Color fundus image
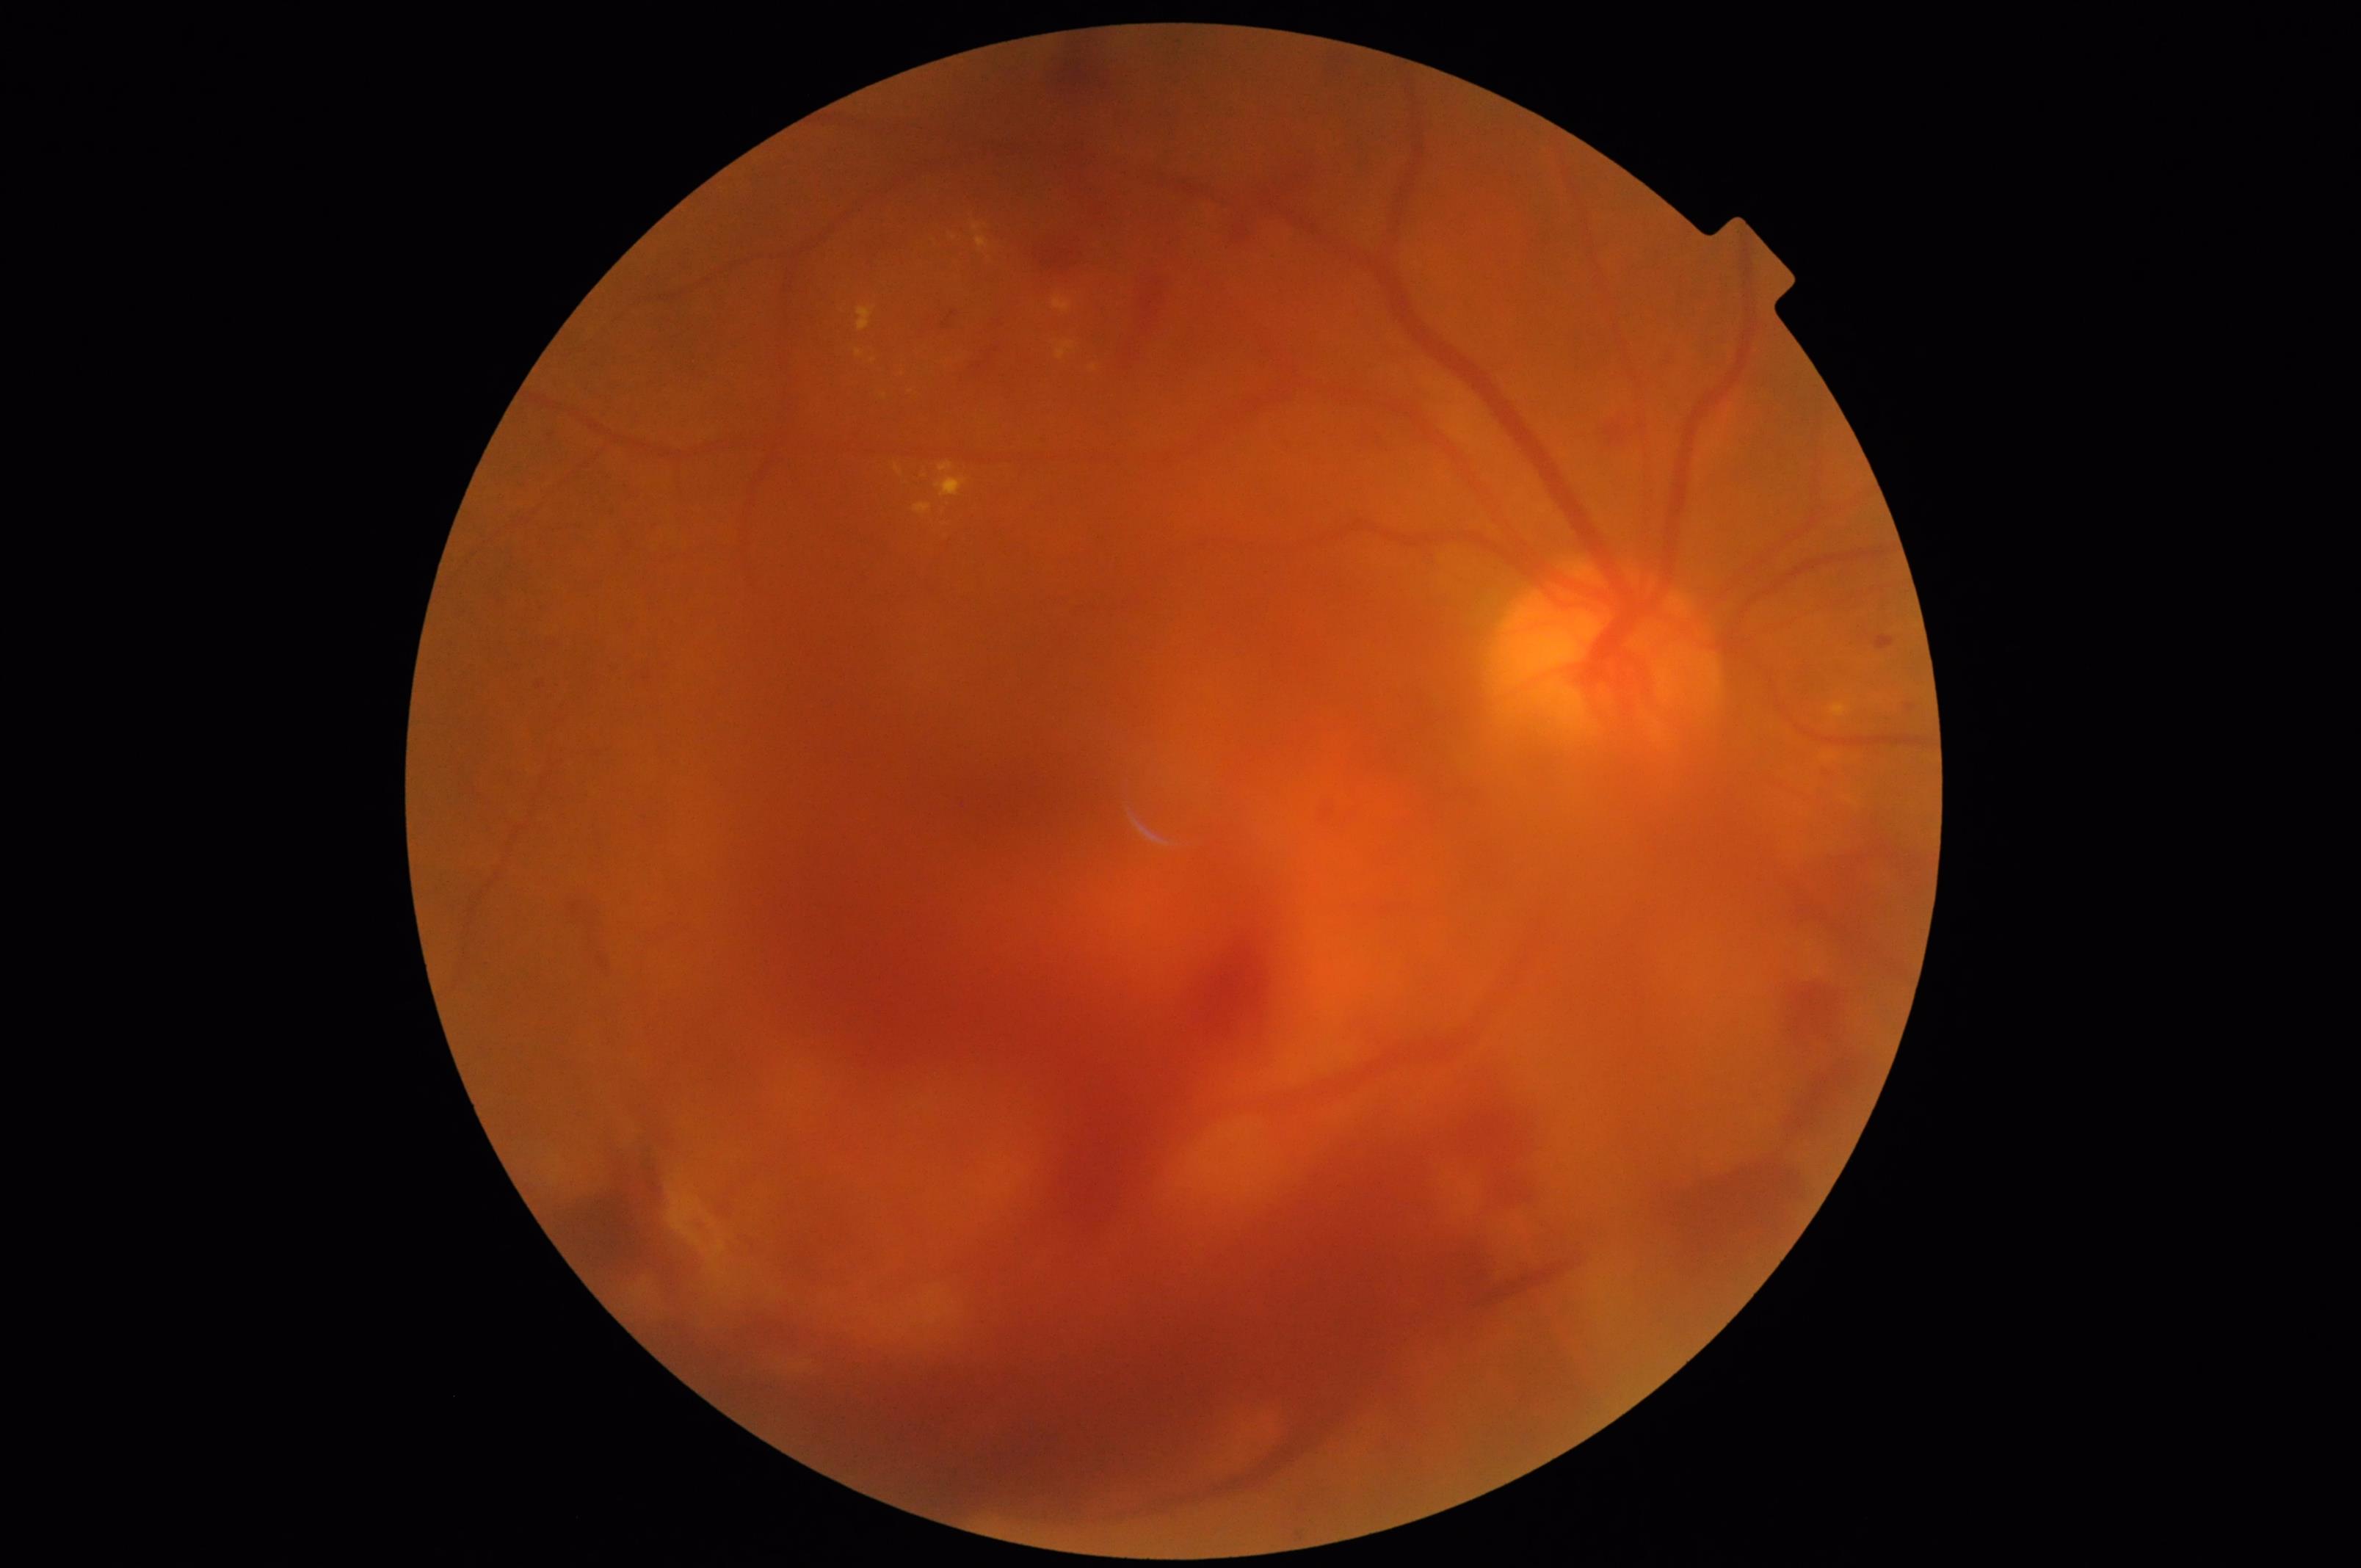

Illumination/color: suboptimal; Sharpness: poor; Overall image quality: low; Contrast: satisfactory.